Wide-field fundus photograph from neonatal ROP screening — 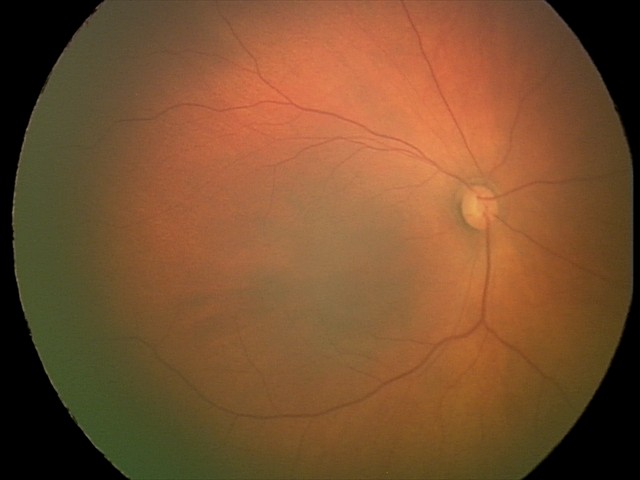

Impression: no pathology identified.